848x848px · graded on the modified Davis scale
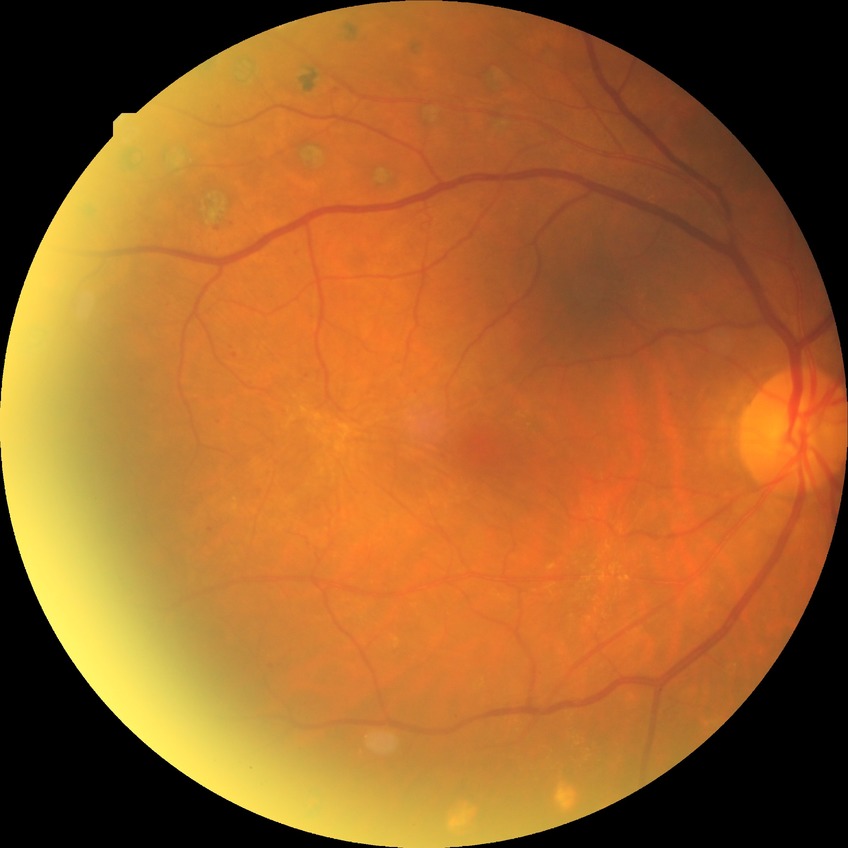
davis_grade: PDR (proliferative diabetic retinopathy)